1659 x 2212 pixels; Remidio Fundus on Phone; fundus photo — 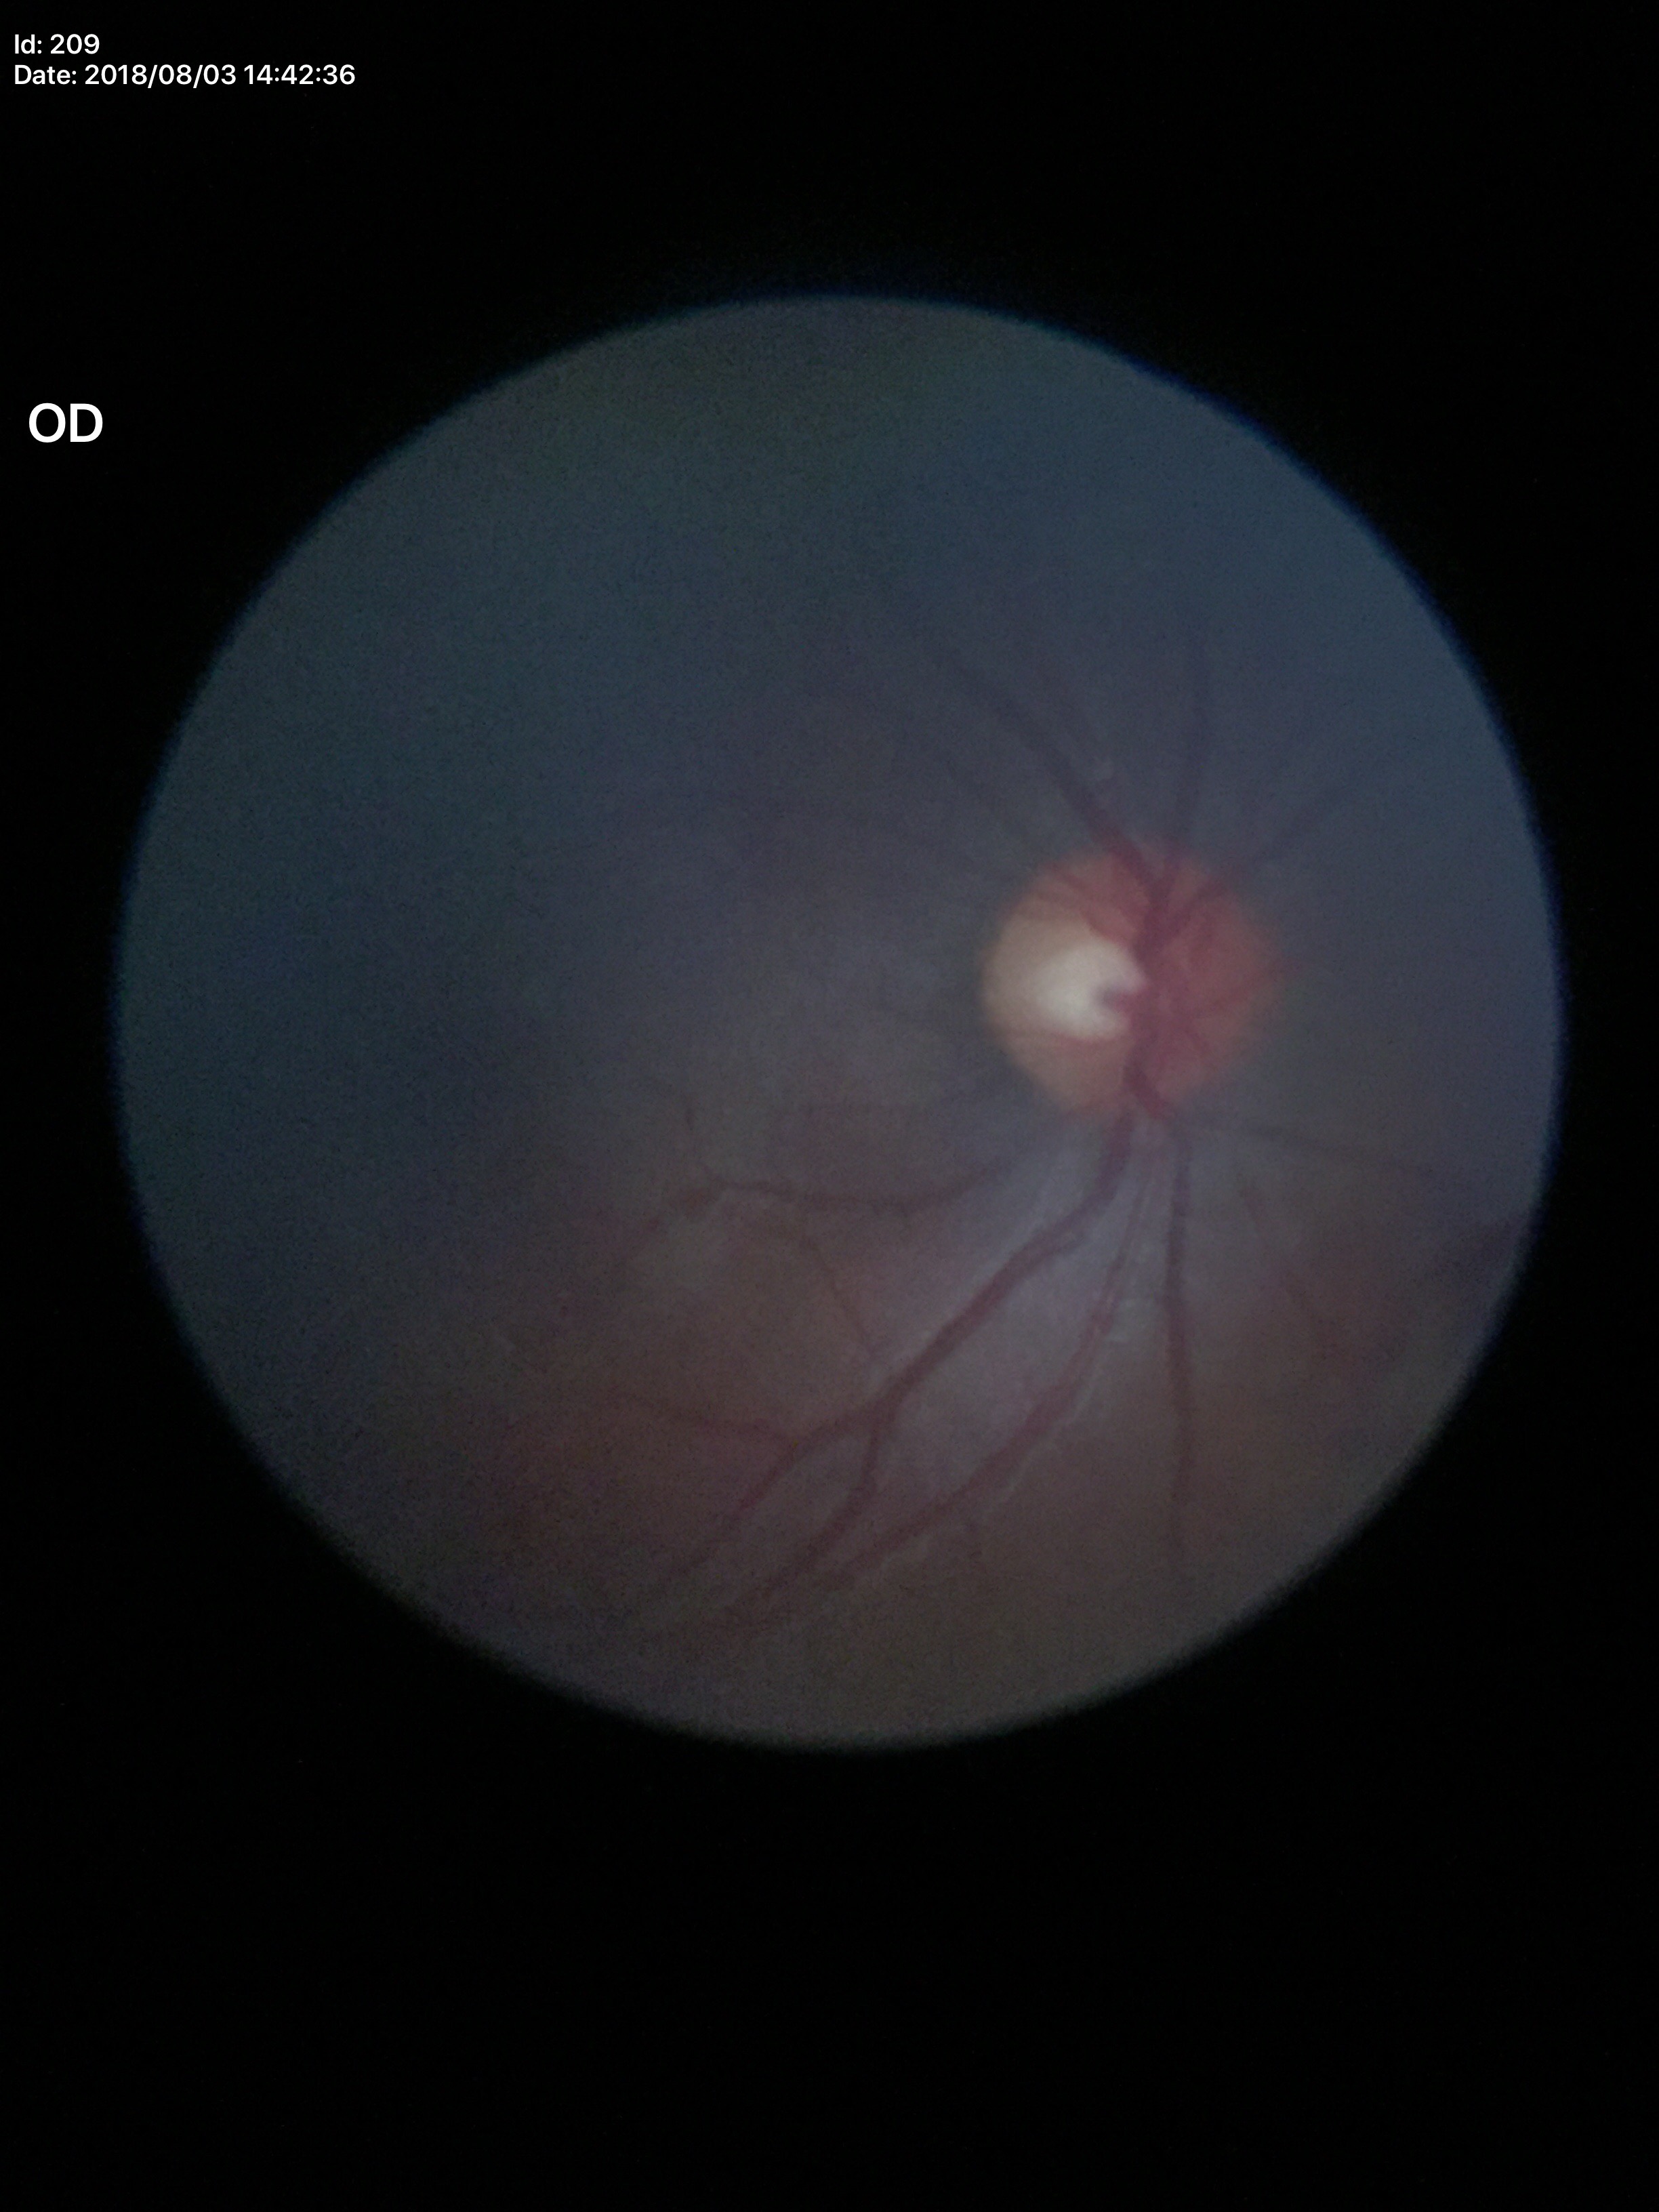

Glaucoma assessment: negative.
VCDR of 0.46.
ACDR: 0.22.